FOV: 45 degrees; 1932 by 1910 pixels — 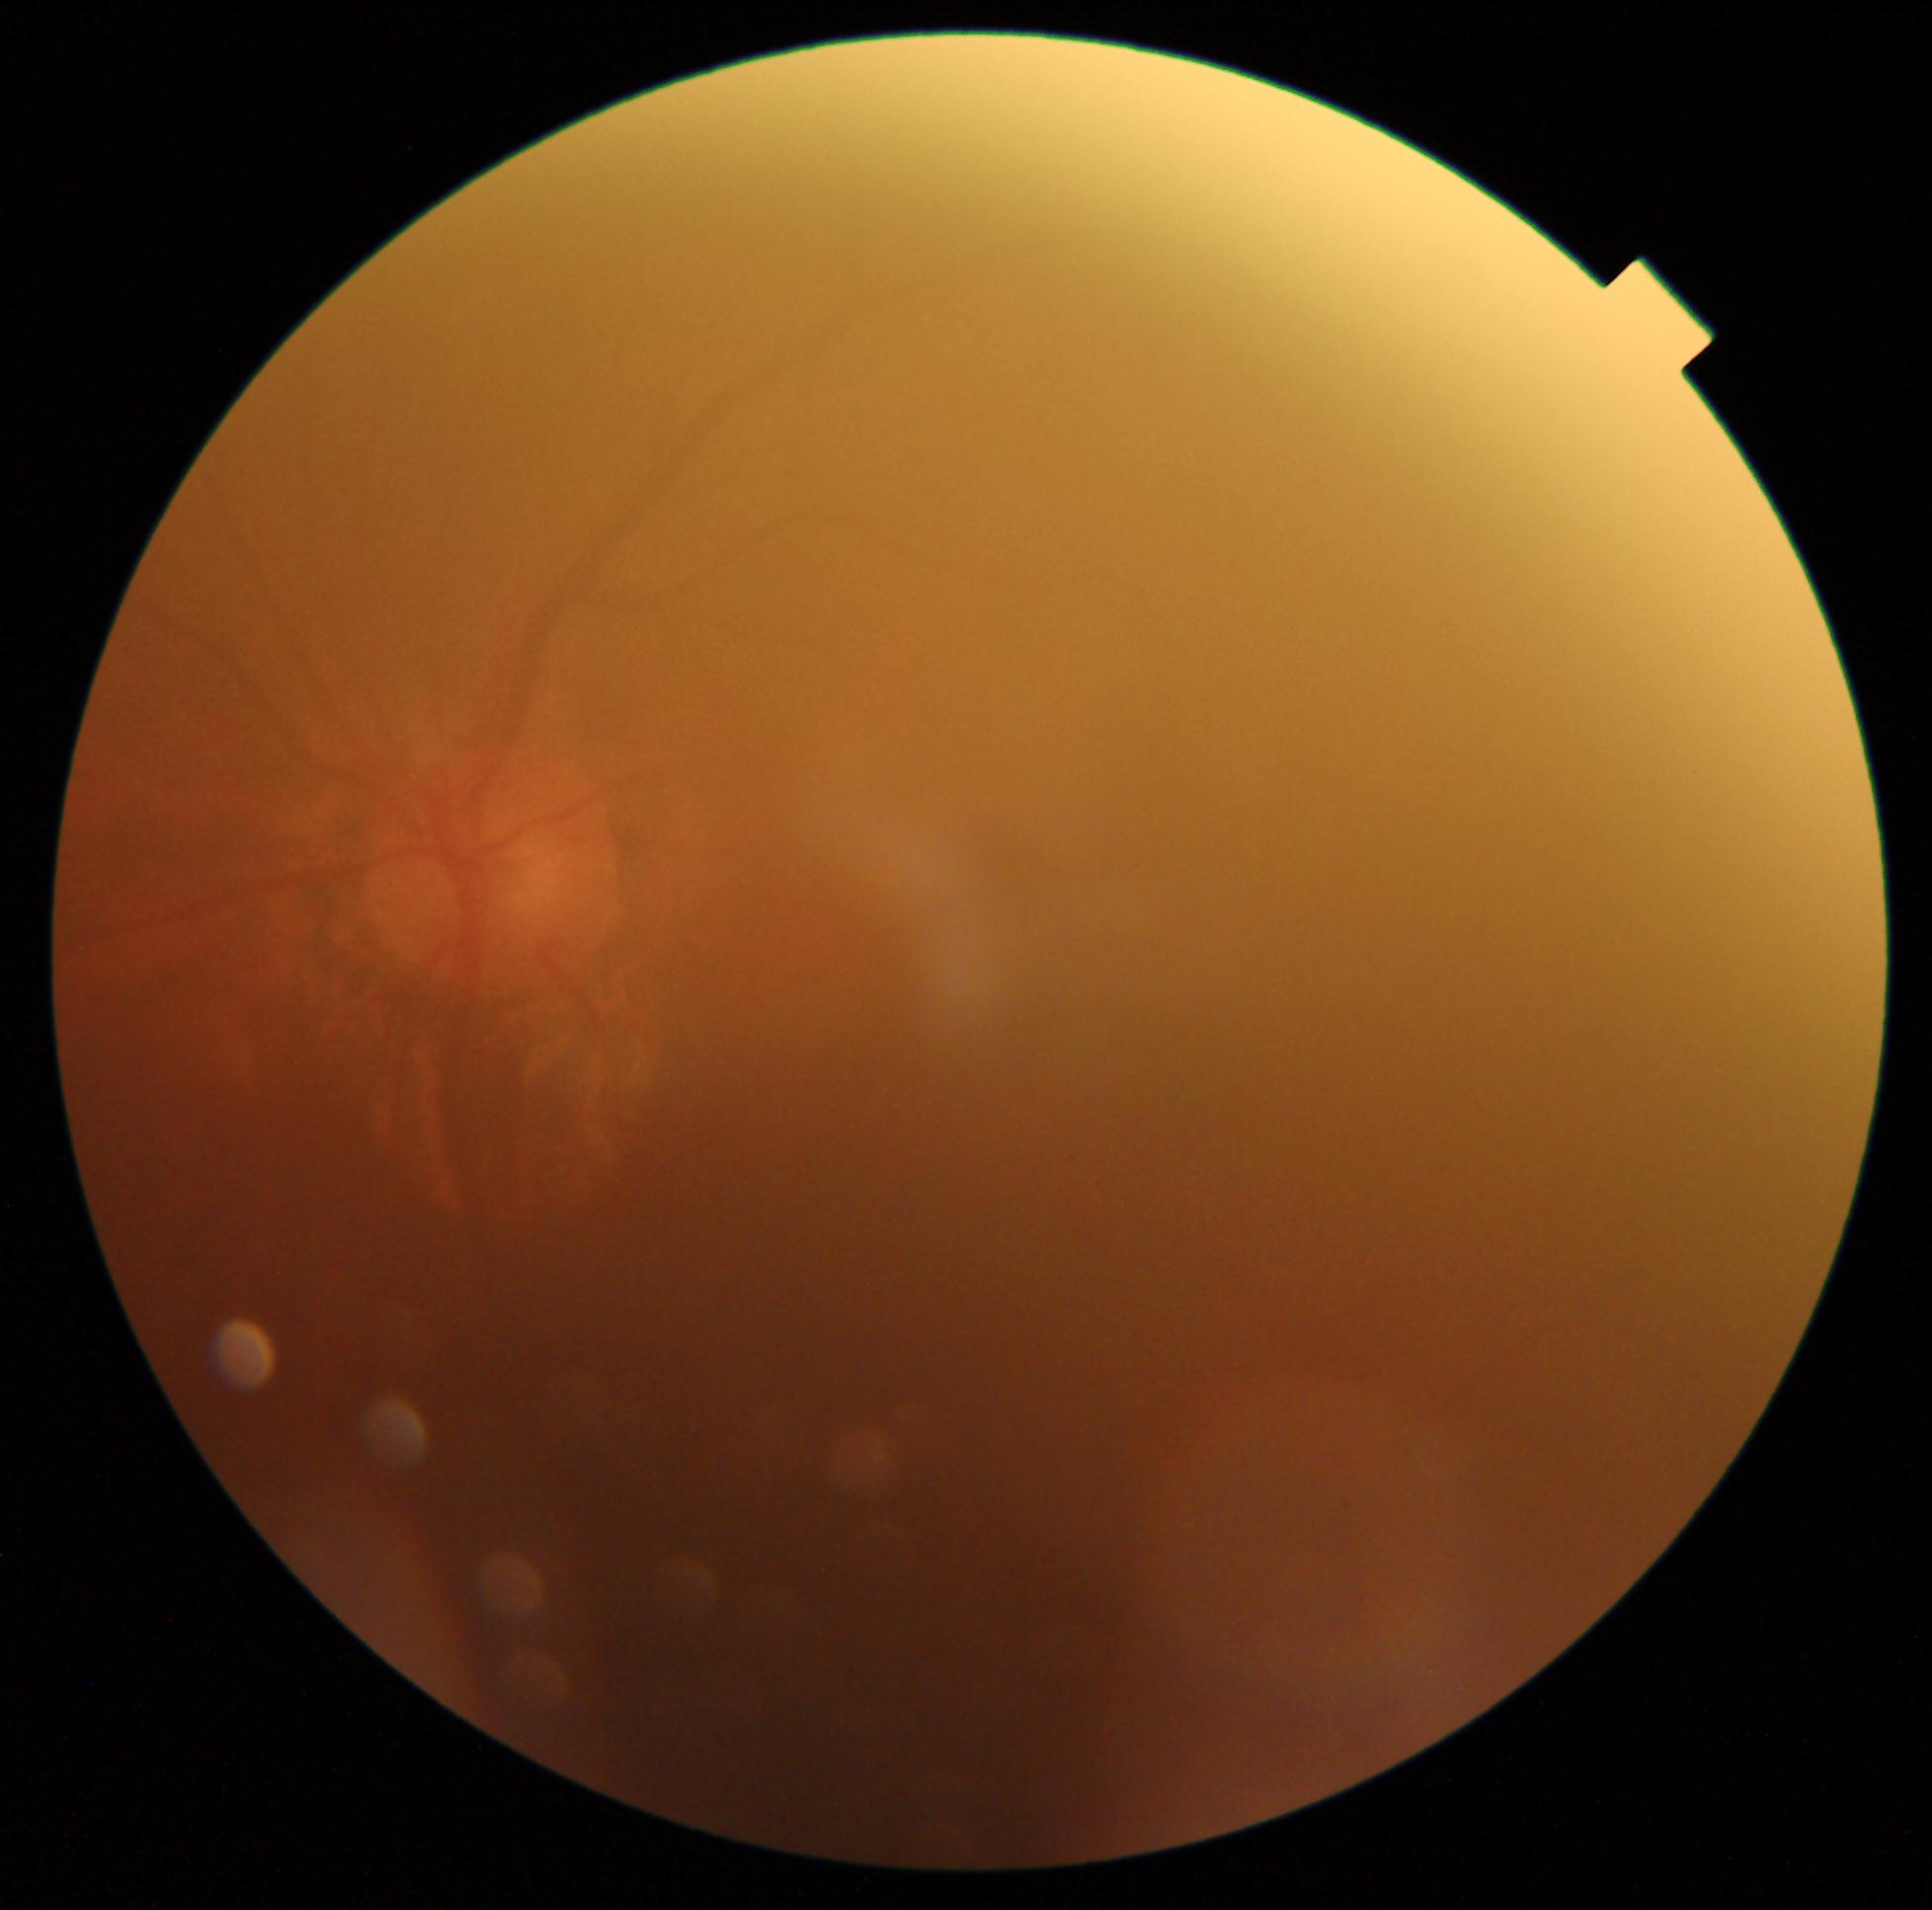
DR severity: ungradable due to poor image quality.